RetCam wide-field infant fundus image; 640x480.
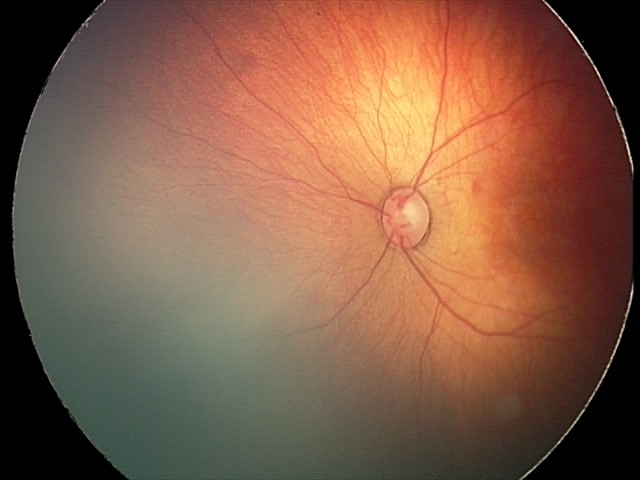
Screening diagnosis: retinal hemorrhages.